Modified Davis grading, retinal fundus photograph, FOV: 45 degrees.
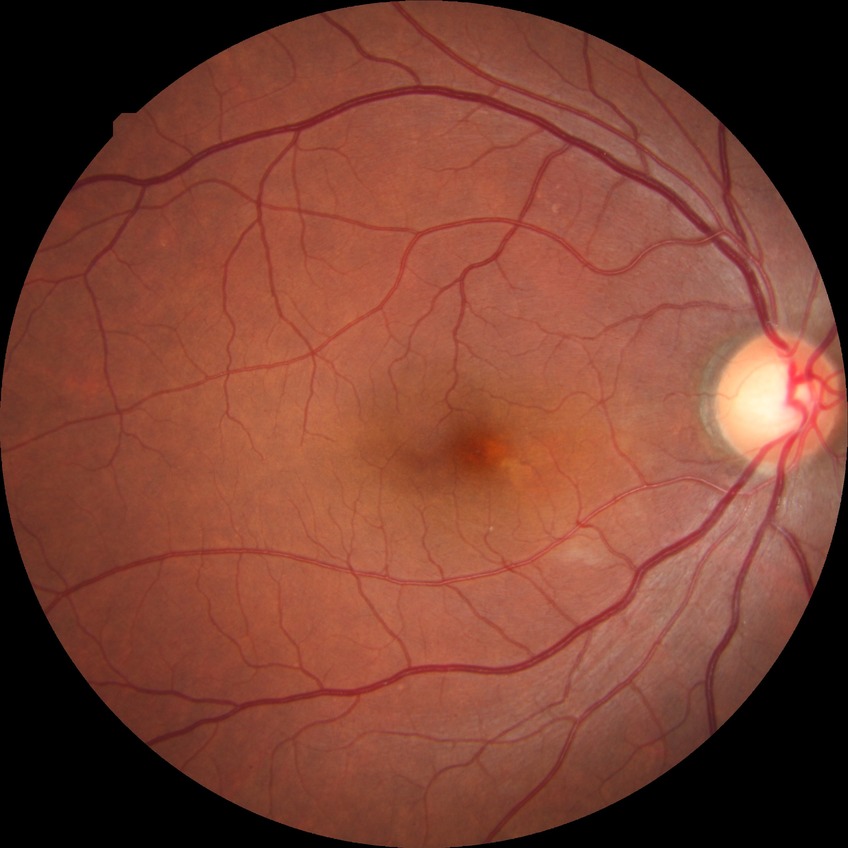
Retinopathy stage: no diabetic retinopathy.